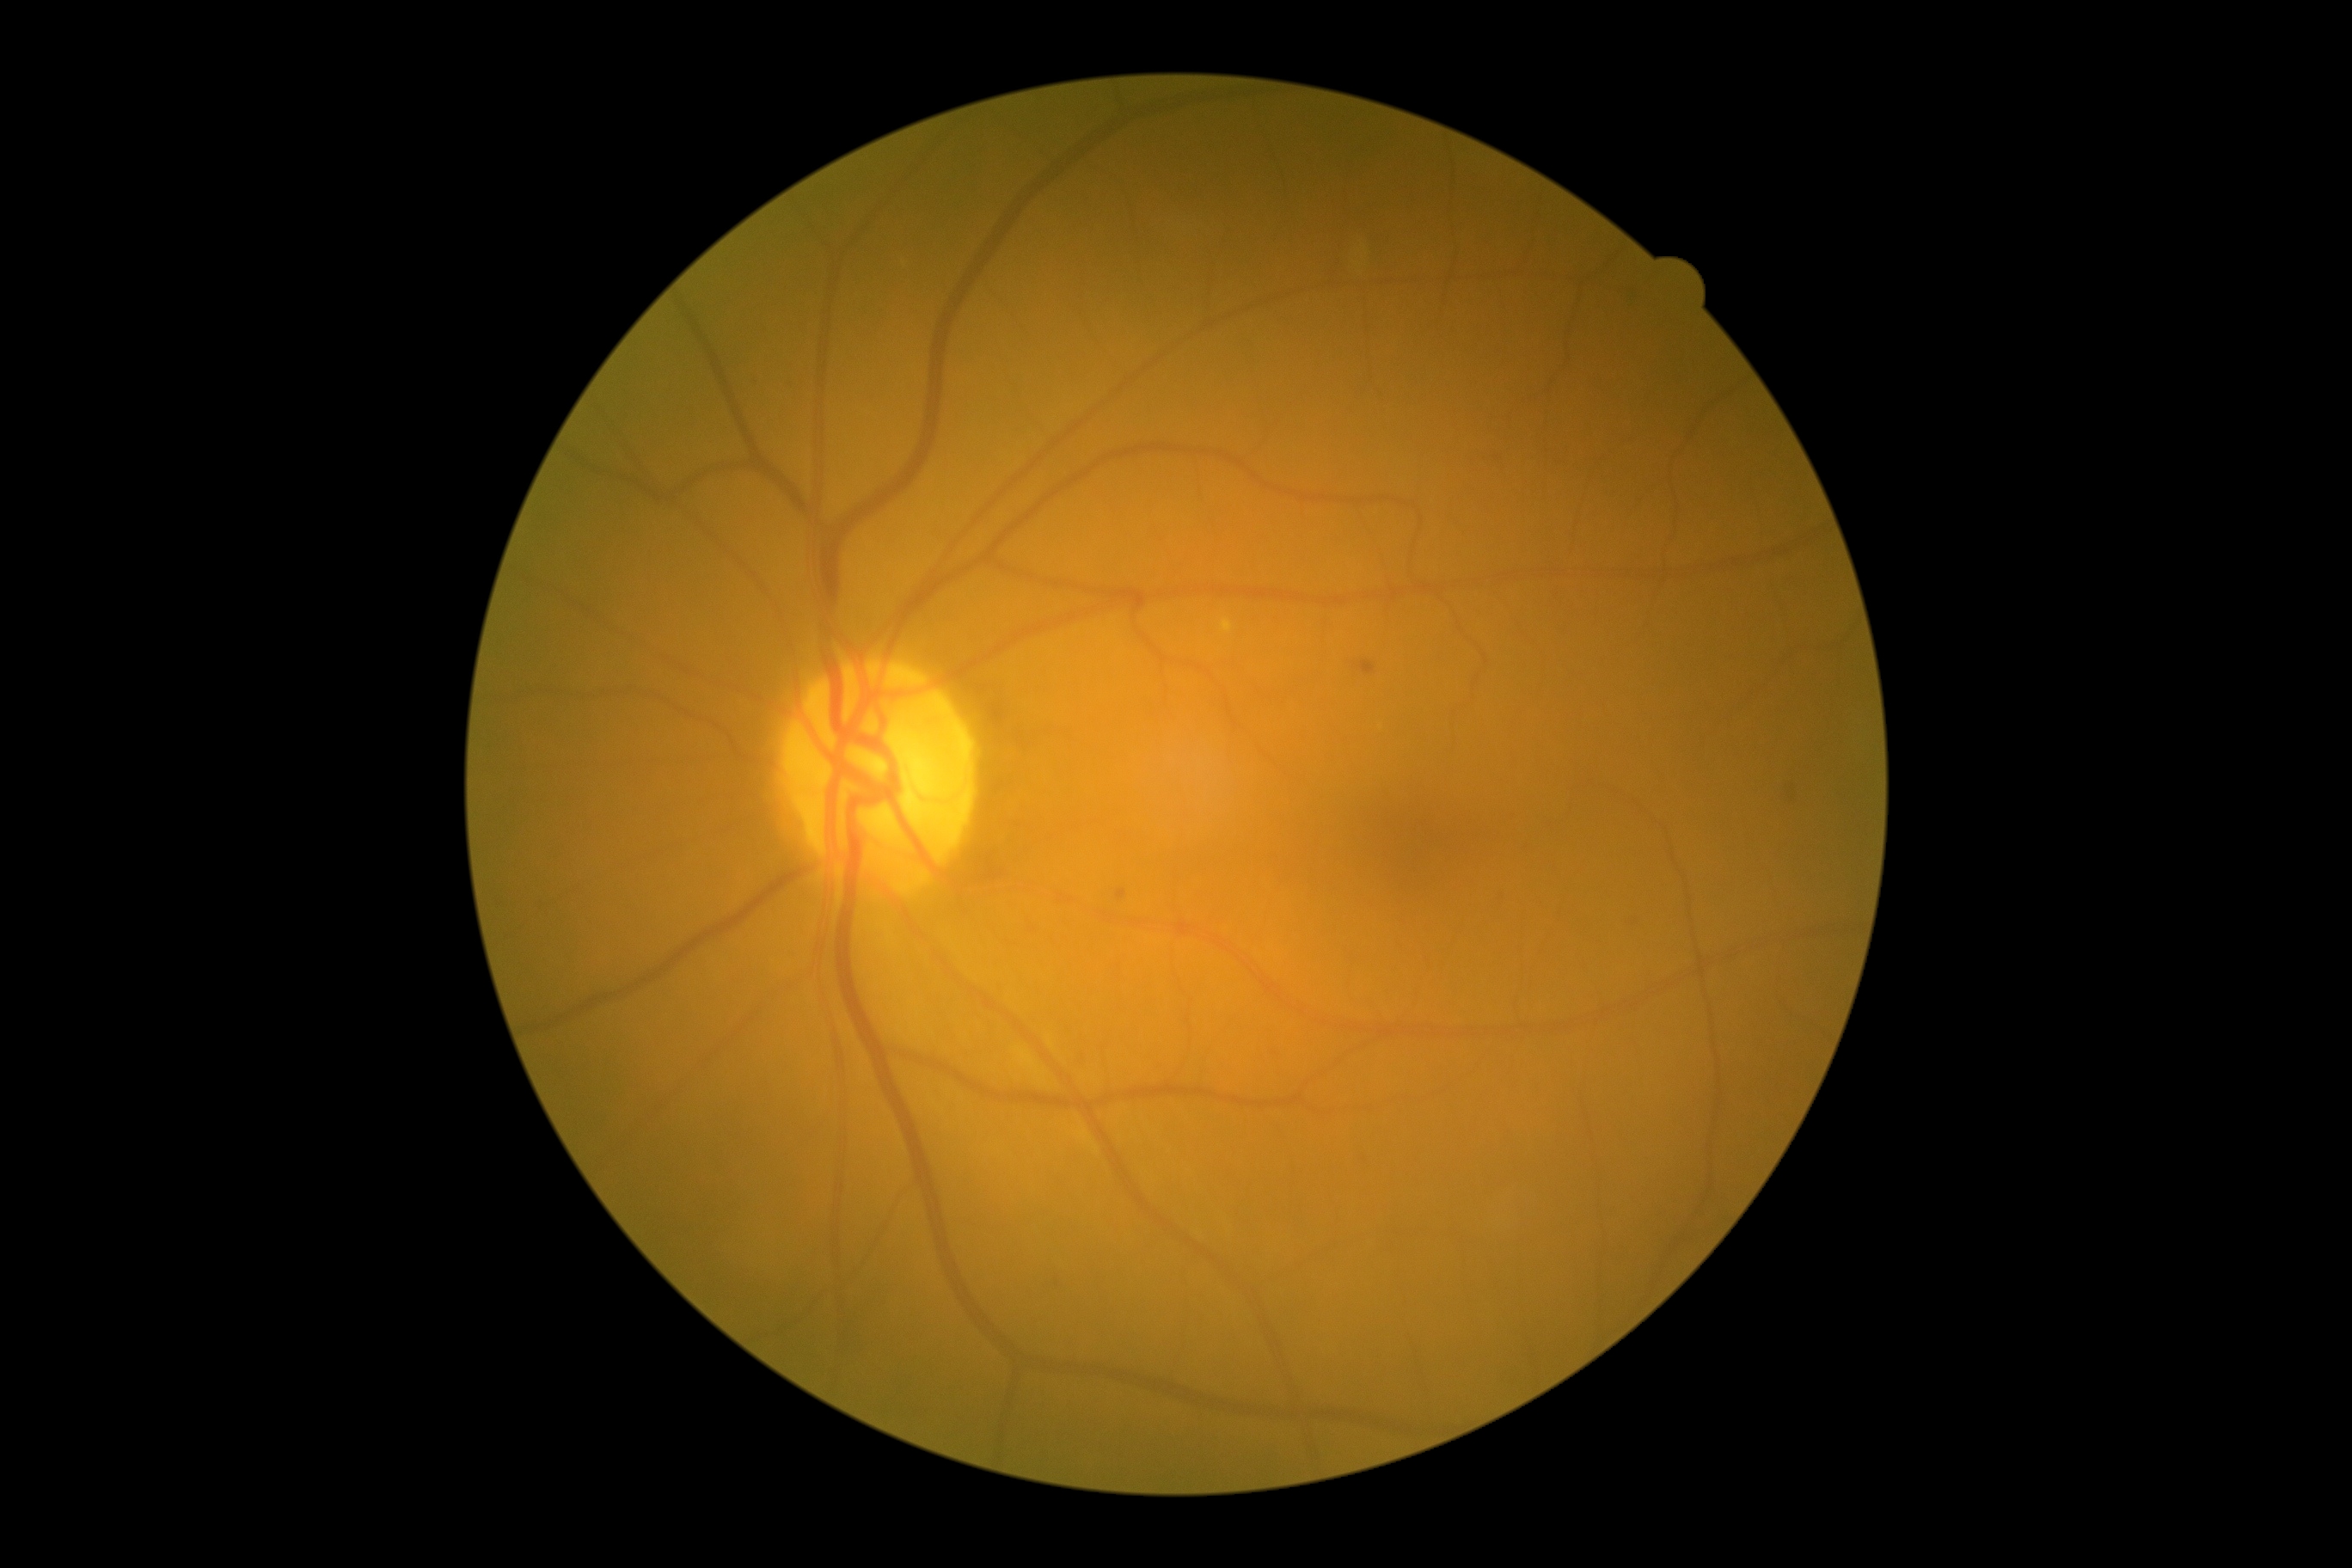
DR impression = no signs of DR, DR = no apparent diabetic retinopathy (grade 0).